45-degree field of view: 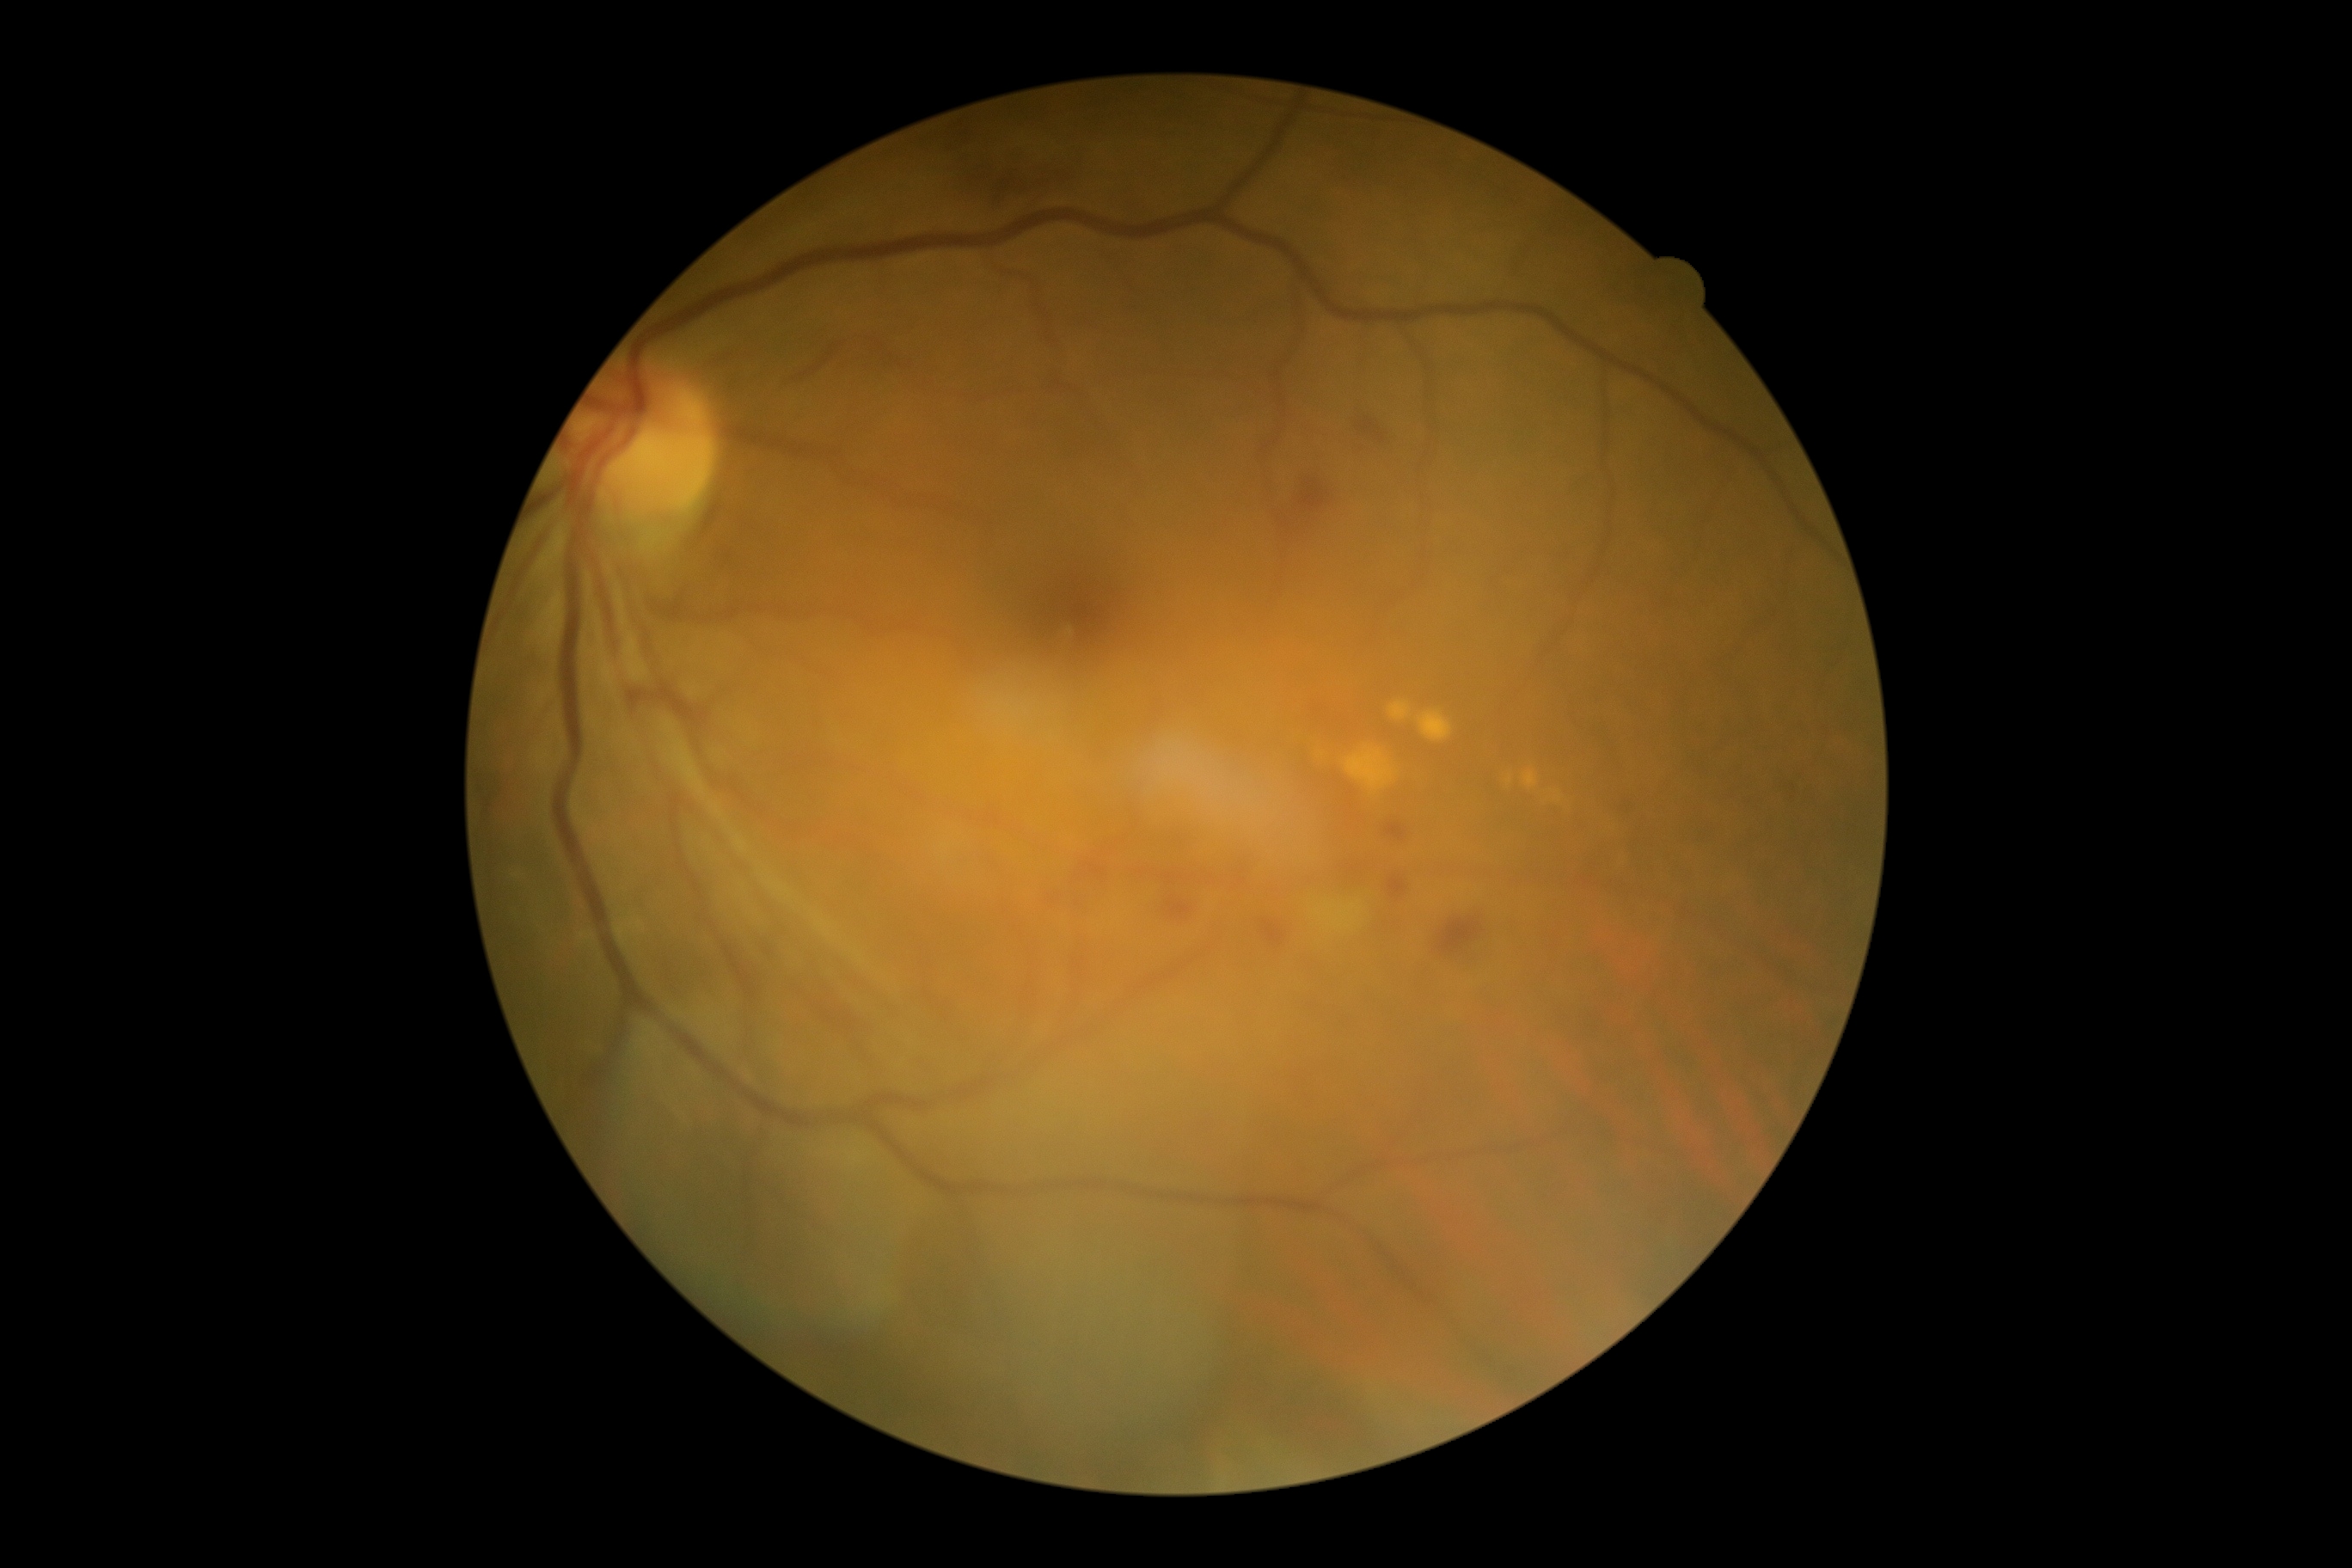

partial: true
dr_grade: 2
dr_grade_name: moderate NPDR
lesions:
  ex: []
  he:
    - left=1388, top=876, right=1407, bottom=898
    - left=1261, top=919, right=1287, bottom=946
    - left=948, top=121, right=1065, bottom=199
    - left=1387, top=824, right=1406, bottom=842
    - left=1438, top=917, right=1485, bottom=955
    - left=1168, top=898, right=1192, bottom=919
    - left=1299, top=481, right=1330, bottom=513
    - left=1082, top=862, right=1105, bottom=876
    - left=1163, top=874, right=1175, bottom=885
    - left=1357, top=419, right=1385, bottom=443
  he_small_centers:
    - x=1350 y=793
    - x=1354 y=869
    - x=1243 y=881
  ma: []
  se: []